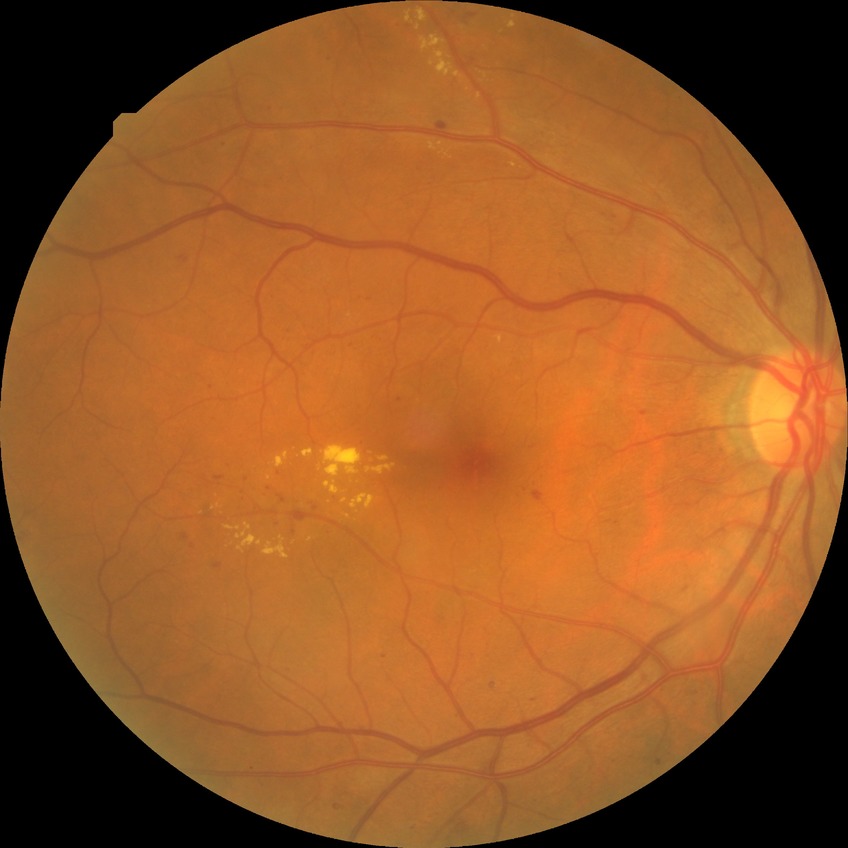 Davis grading is proliferative diabetic retinopathy.